Modified Davis grading — 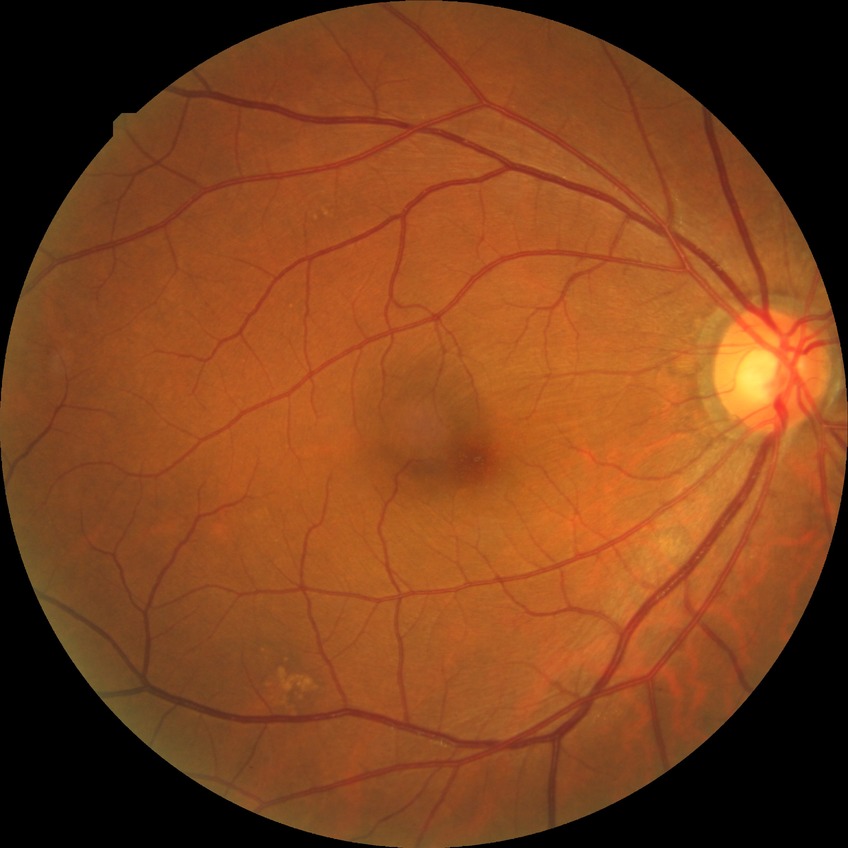

No DR findings. Modified Davis grade is NDR.